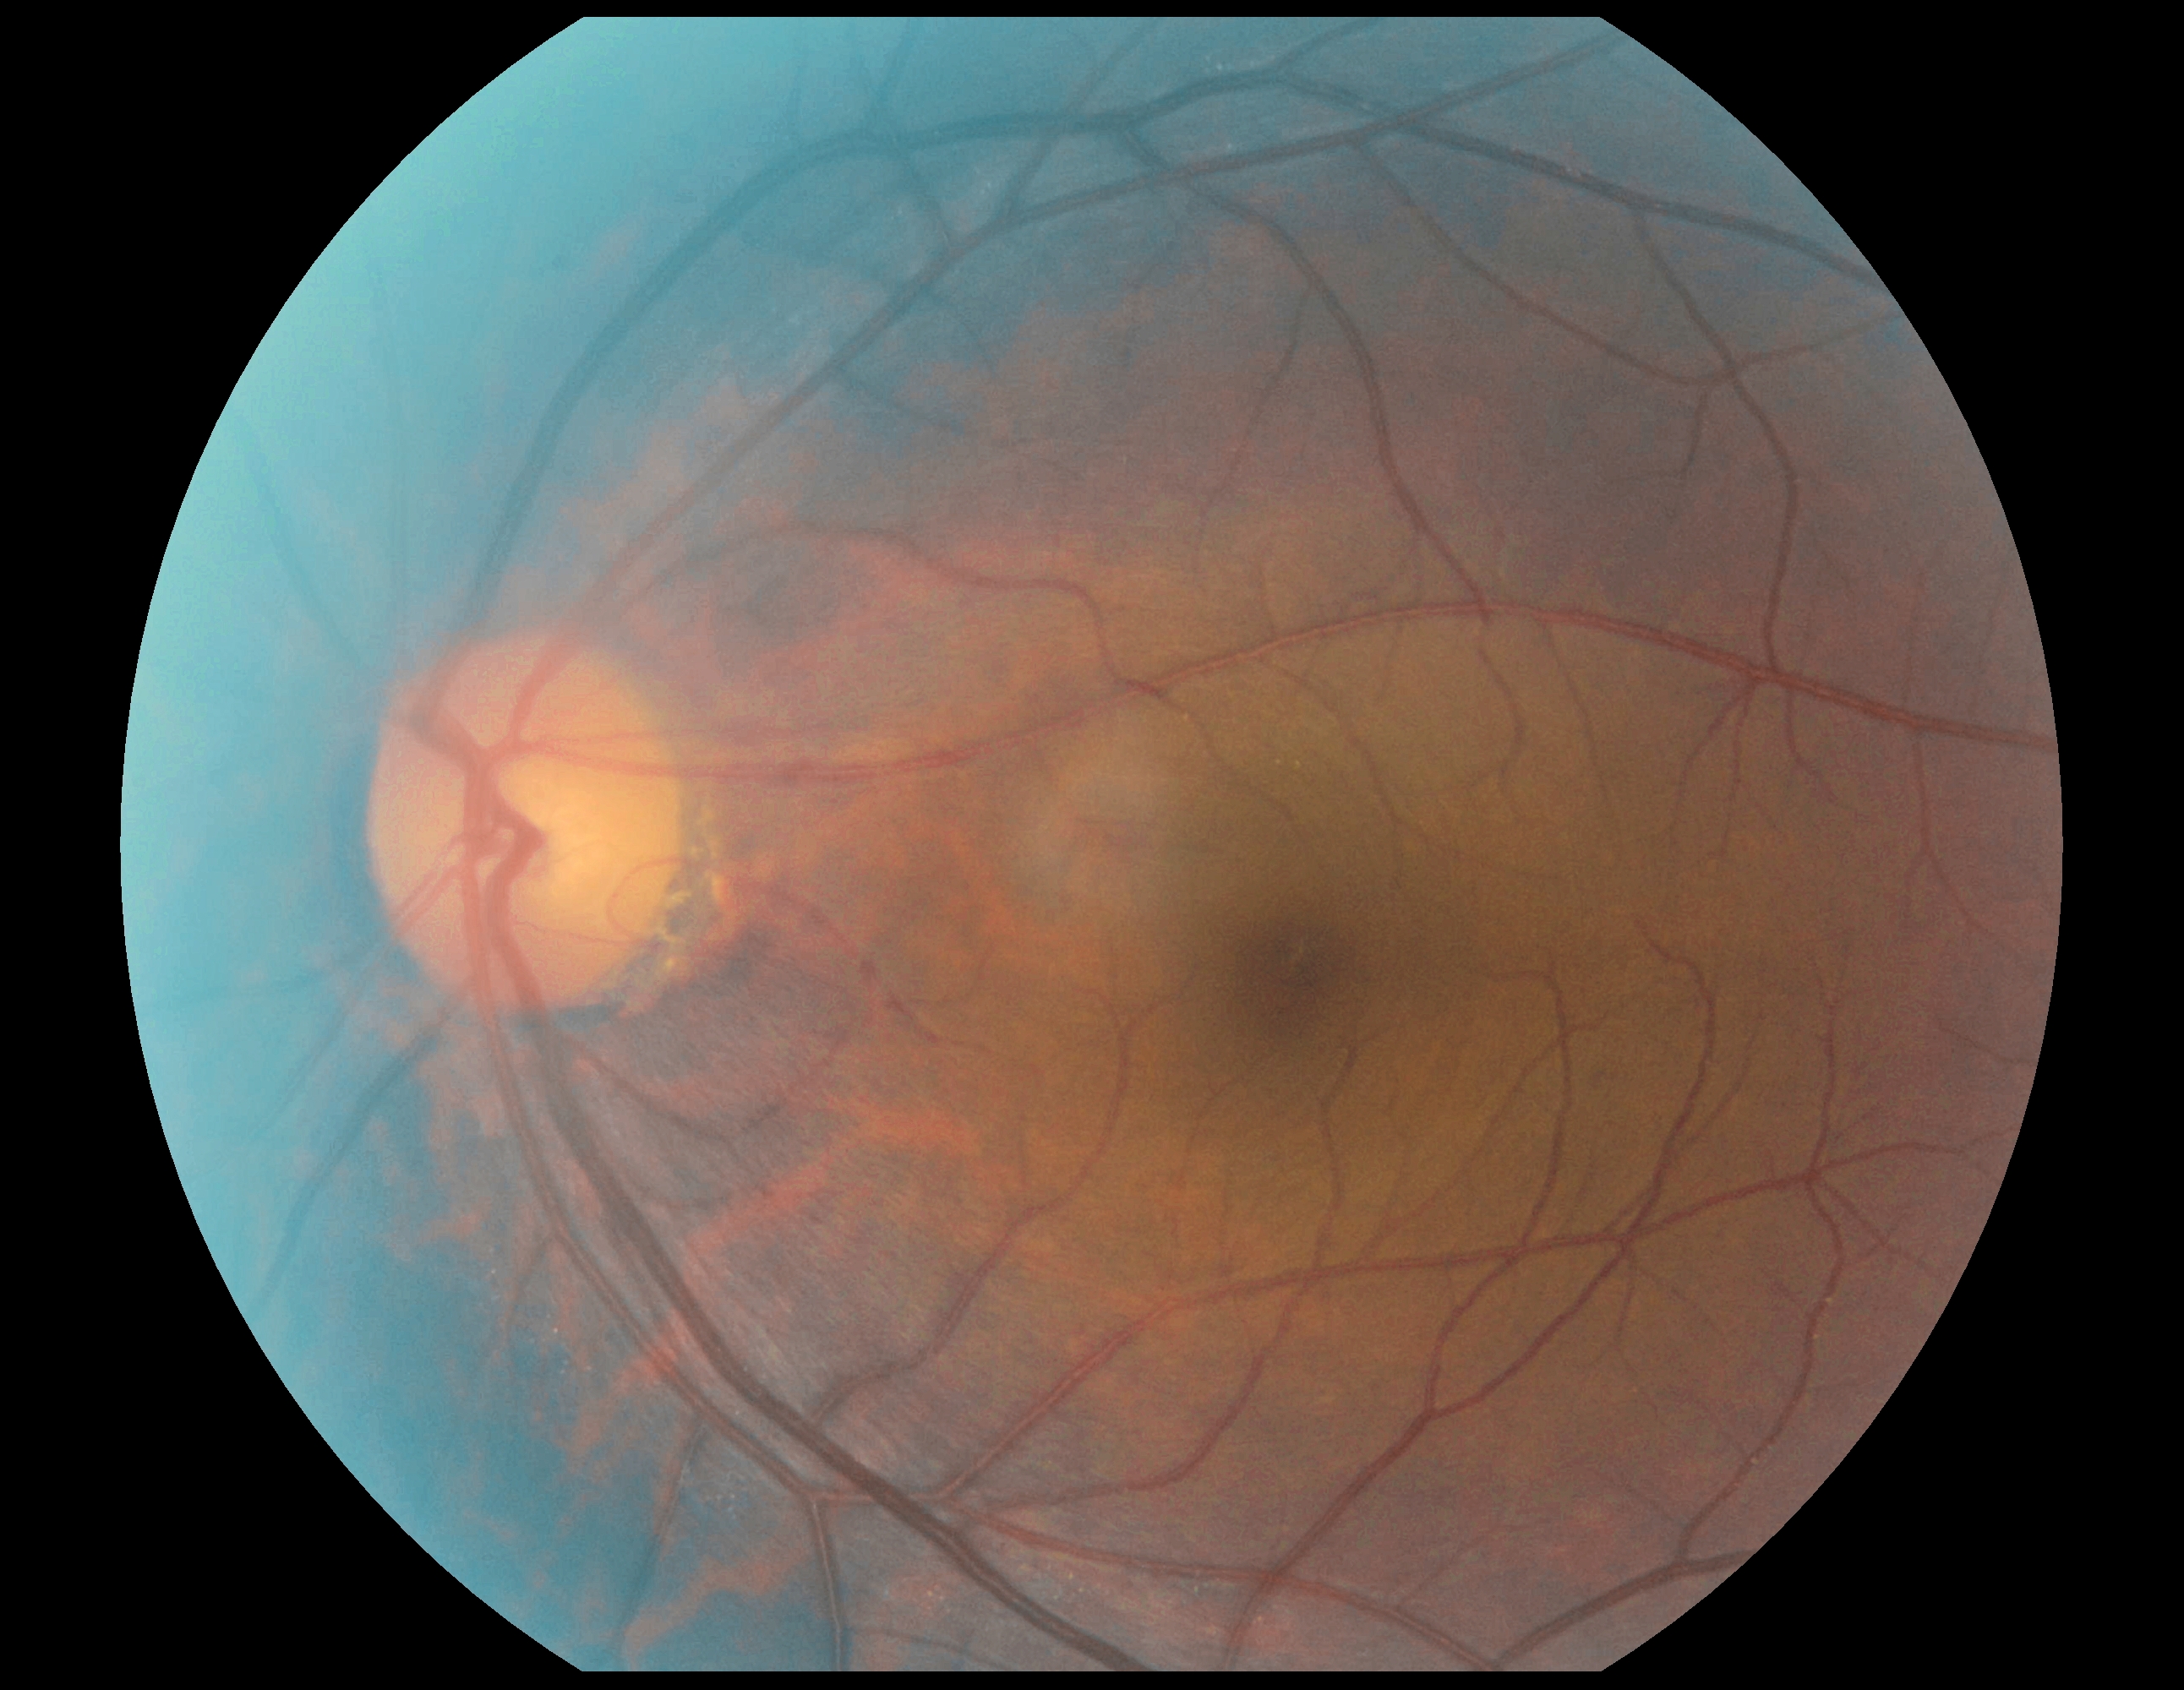
DR impression@negative for DR; diabetic retinopathy grade@0 (no apparent retinopathy).